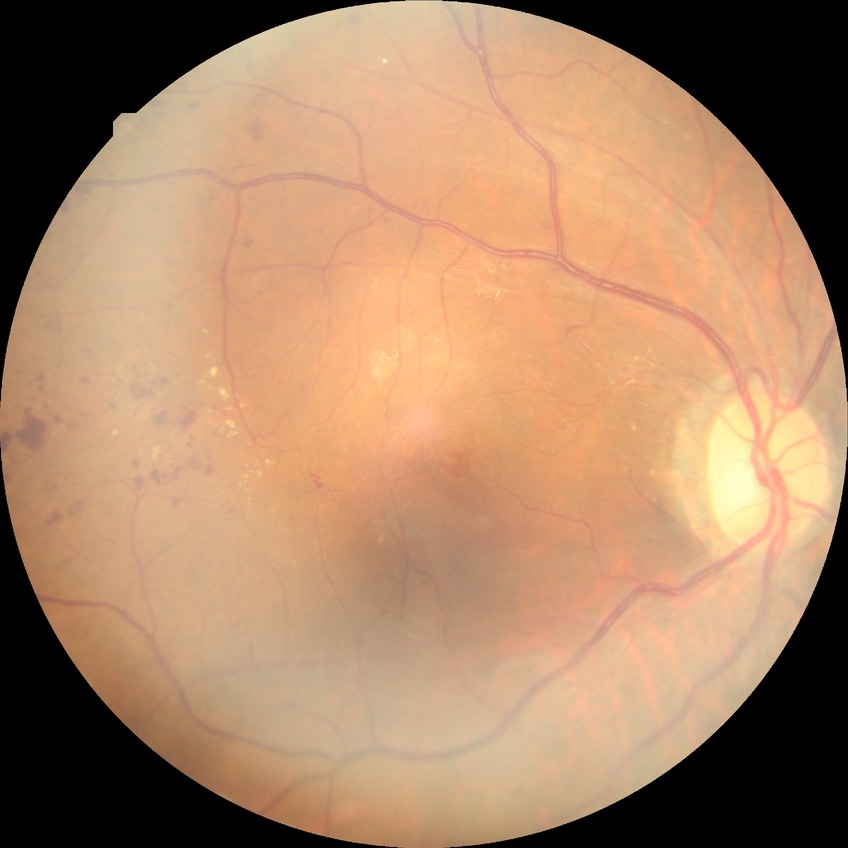 Davis DR grade = SDR.